Davis DR grading; 848x848 — 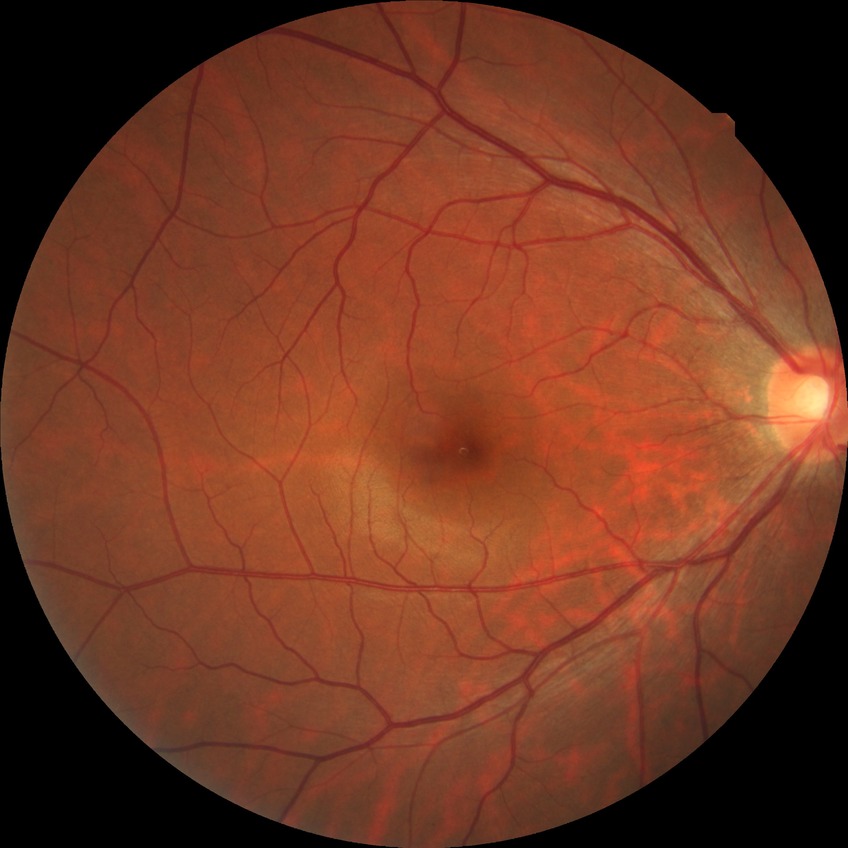
DR grade is NDR.